FOV: 45 degrees, 848 by 848 pixels — 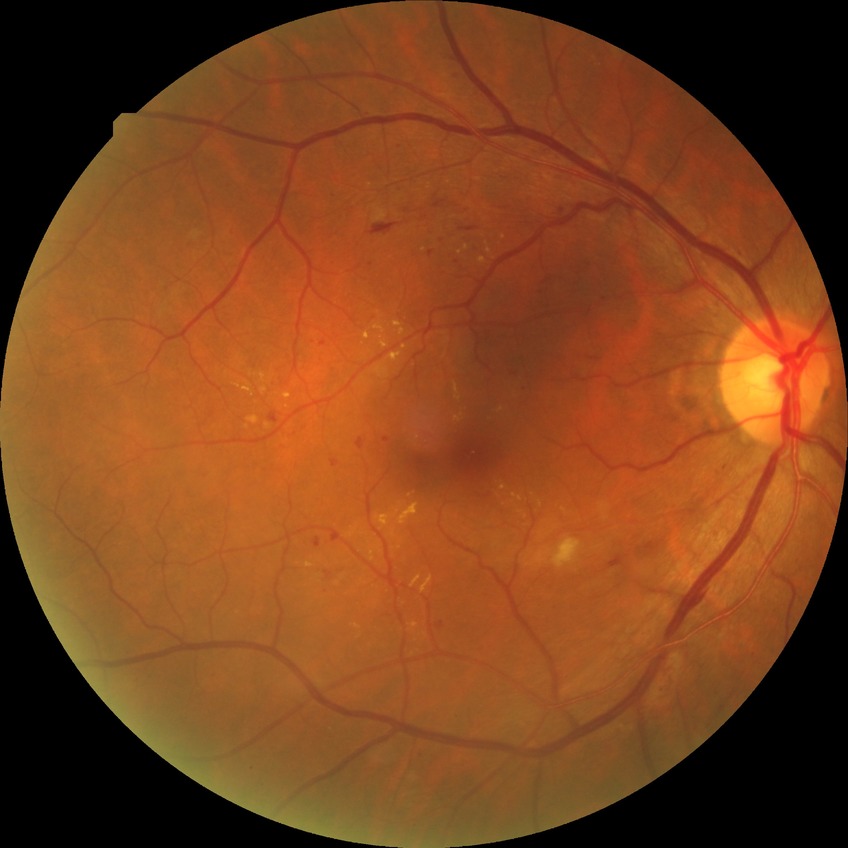
DR class = non-proliferative diabetic retinopathy; retinopathy stage = pre-proliferative diabetic retinopathy.